45° FOV, color fundus photograph
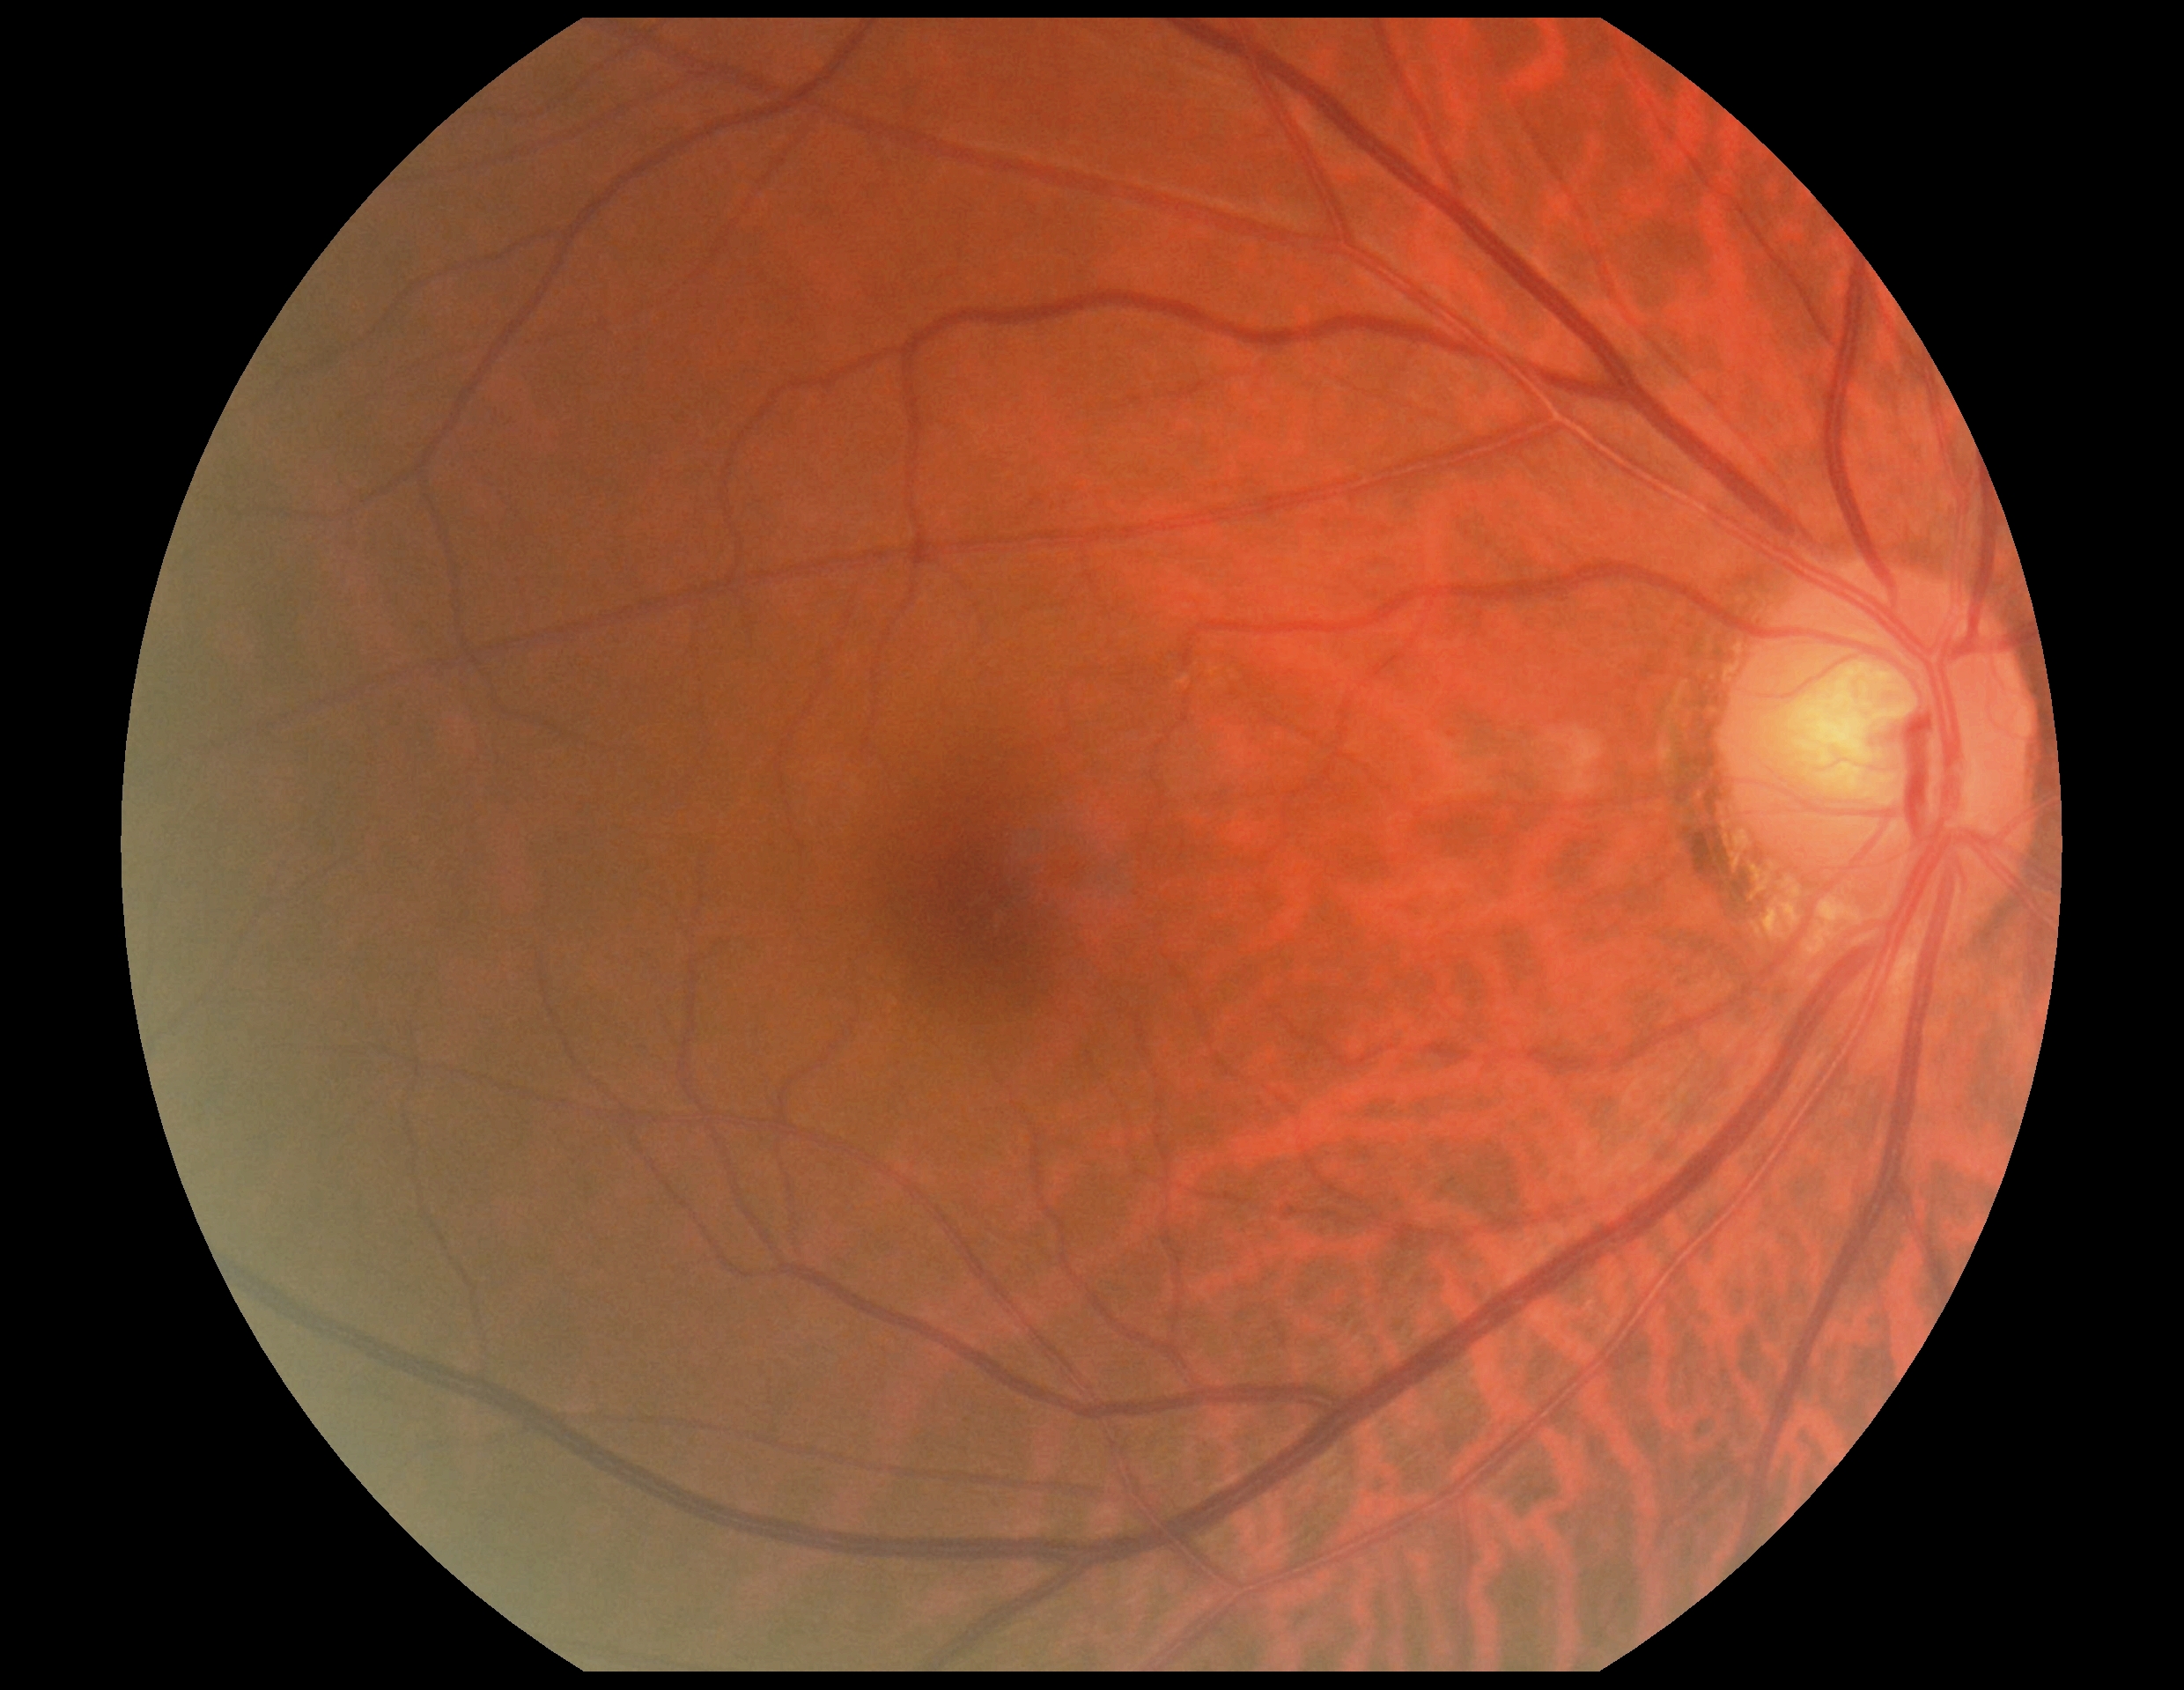

No apparent diabetic retinopathy.
Retinopathy grade: 0/4.